848 x 848 pixels. Davis DR grading. NIDEK AFC-230 fundus camera. 45° FOV. Nonmydriatic fundus photograph. Posterior pole color fundus photograph
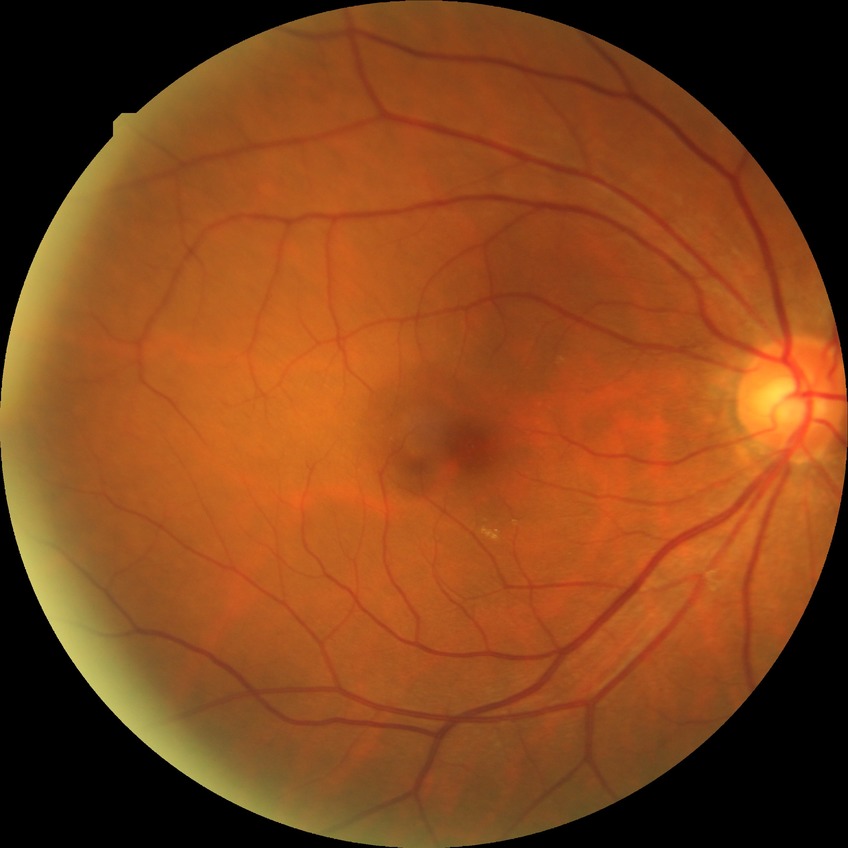
Diabetic retinopathy (DR) is NDR (no diabetic retinopathy).